Color fundus photograph
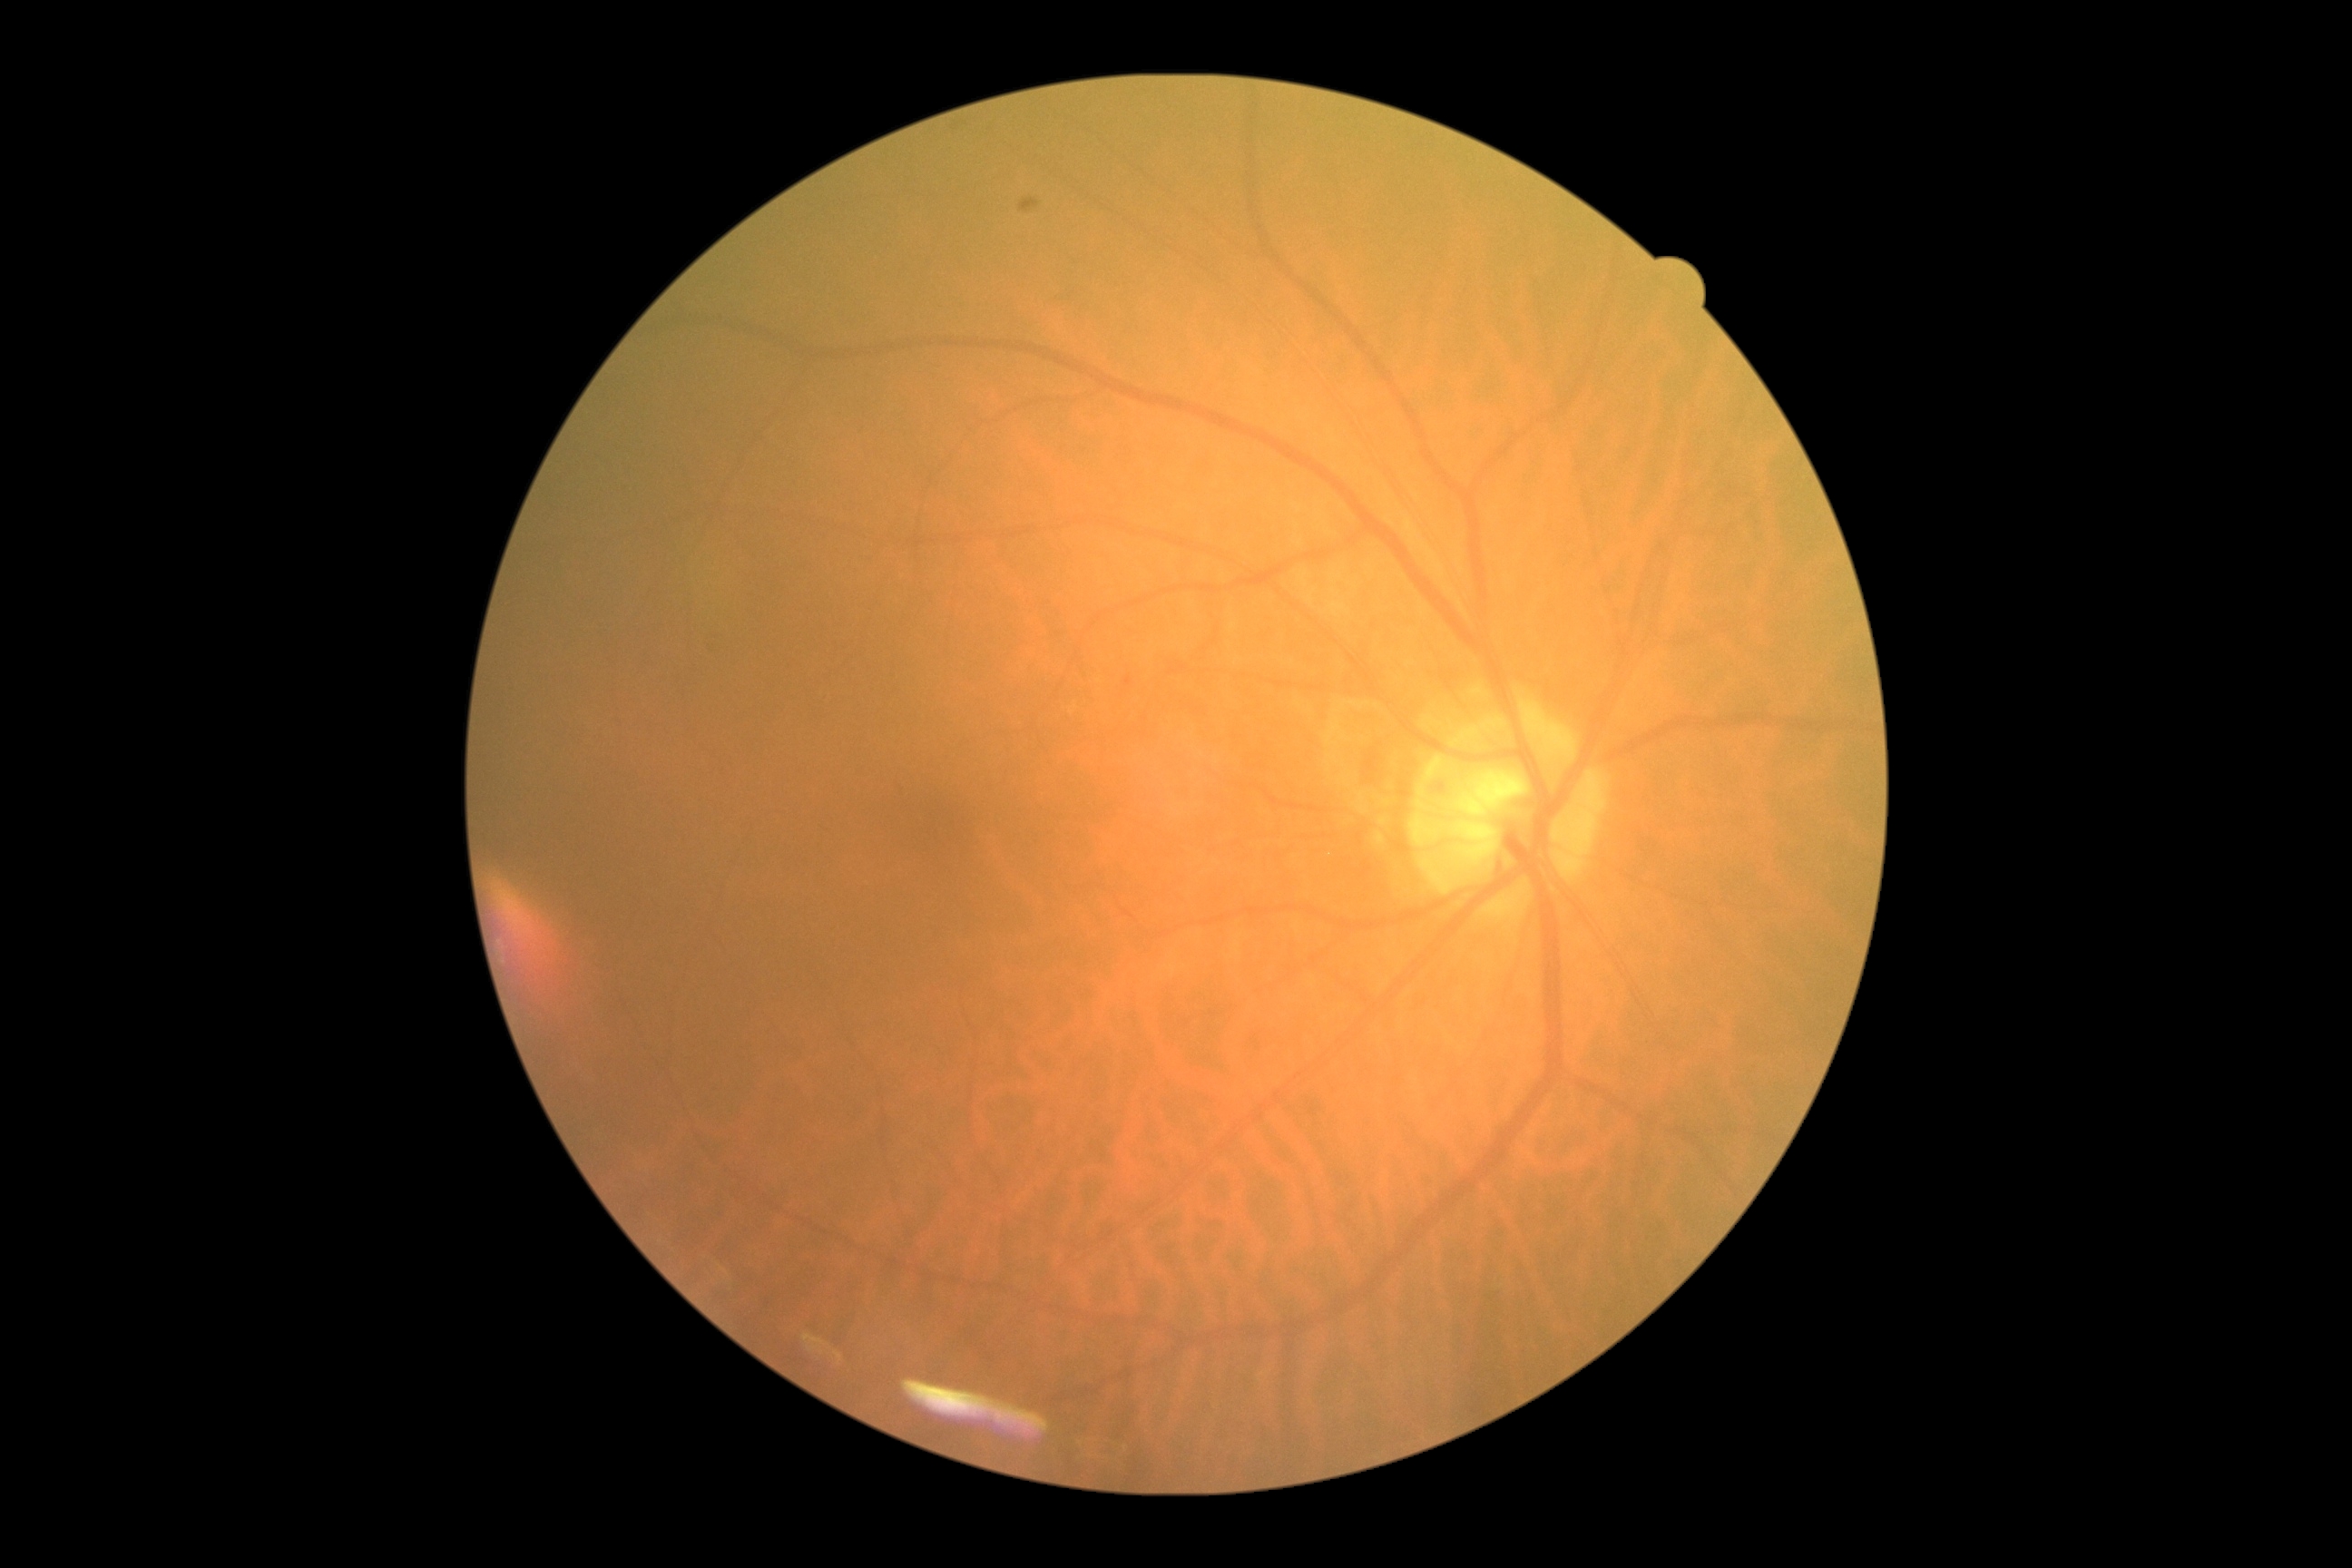

Diabetic retinopathy grade: 0 (no apparent retinopathy) — no visible signs of diabetic retinopathy.
No signs of diabetic retinopathy.